Acquired on the Phoenix ICON. 1240 x 1240 pixels. Wide-field fundus photograph of an infant — 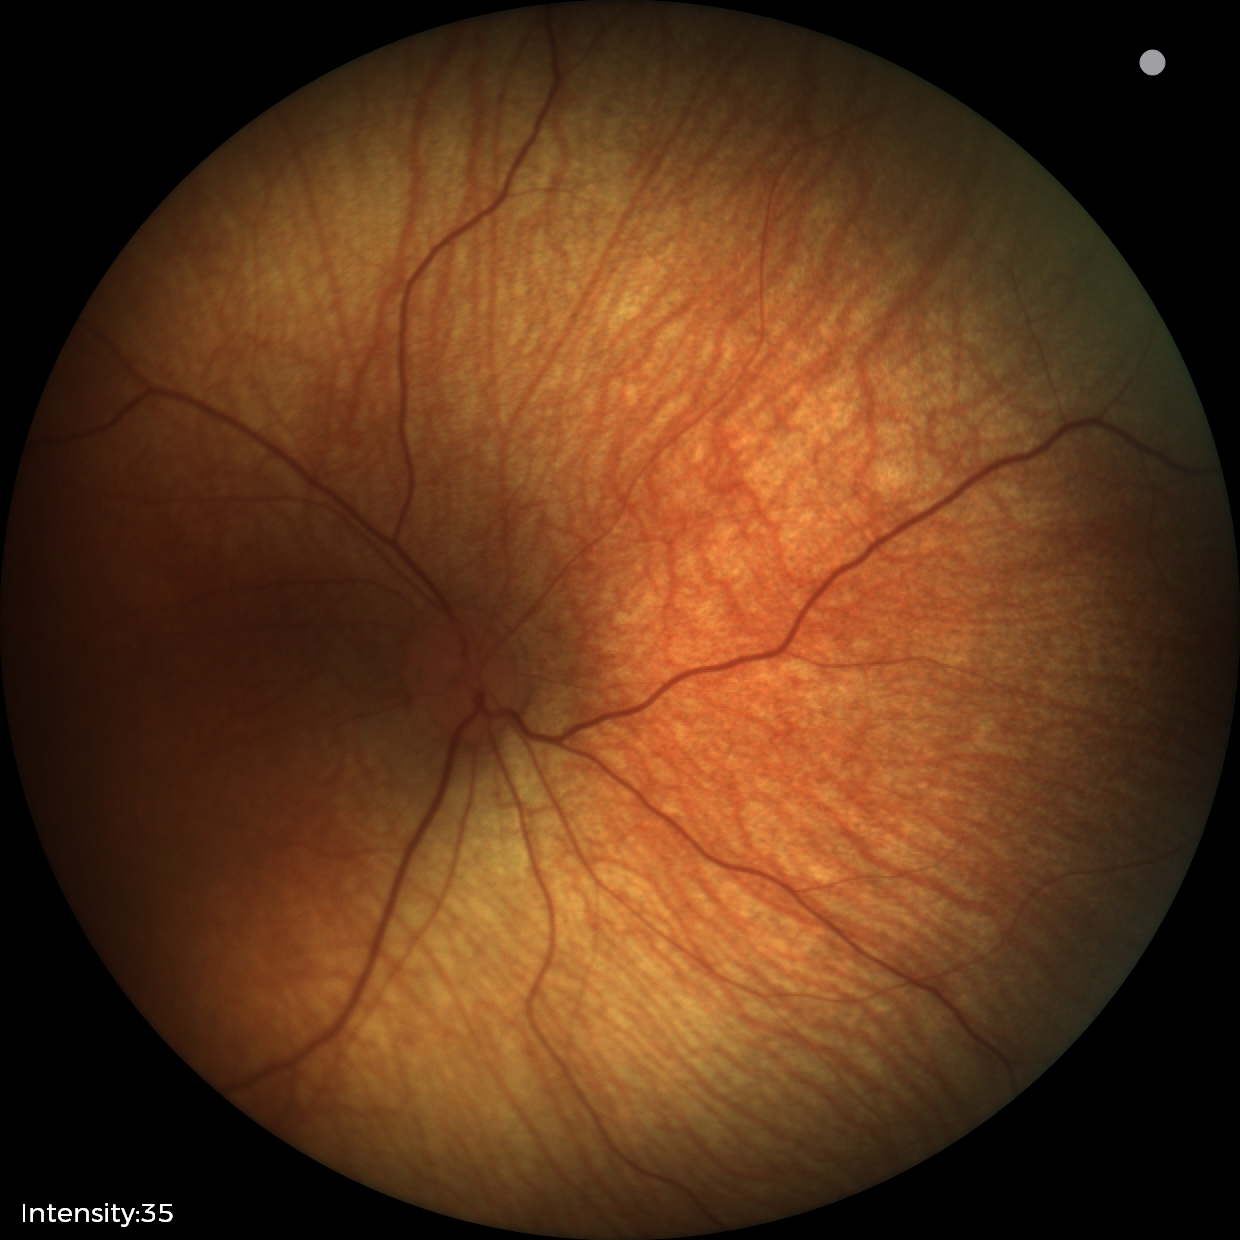
Screening diagnosis: normal fundus examination.